45° FOV — 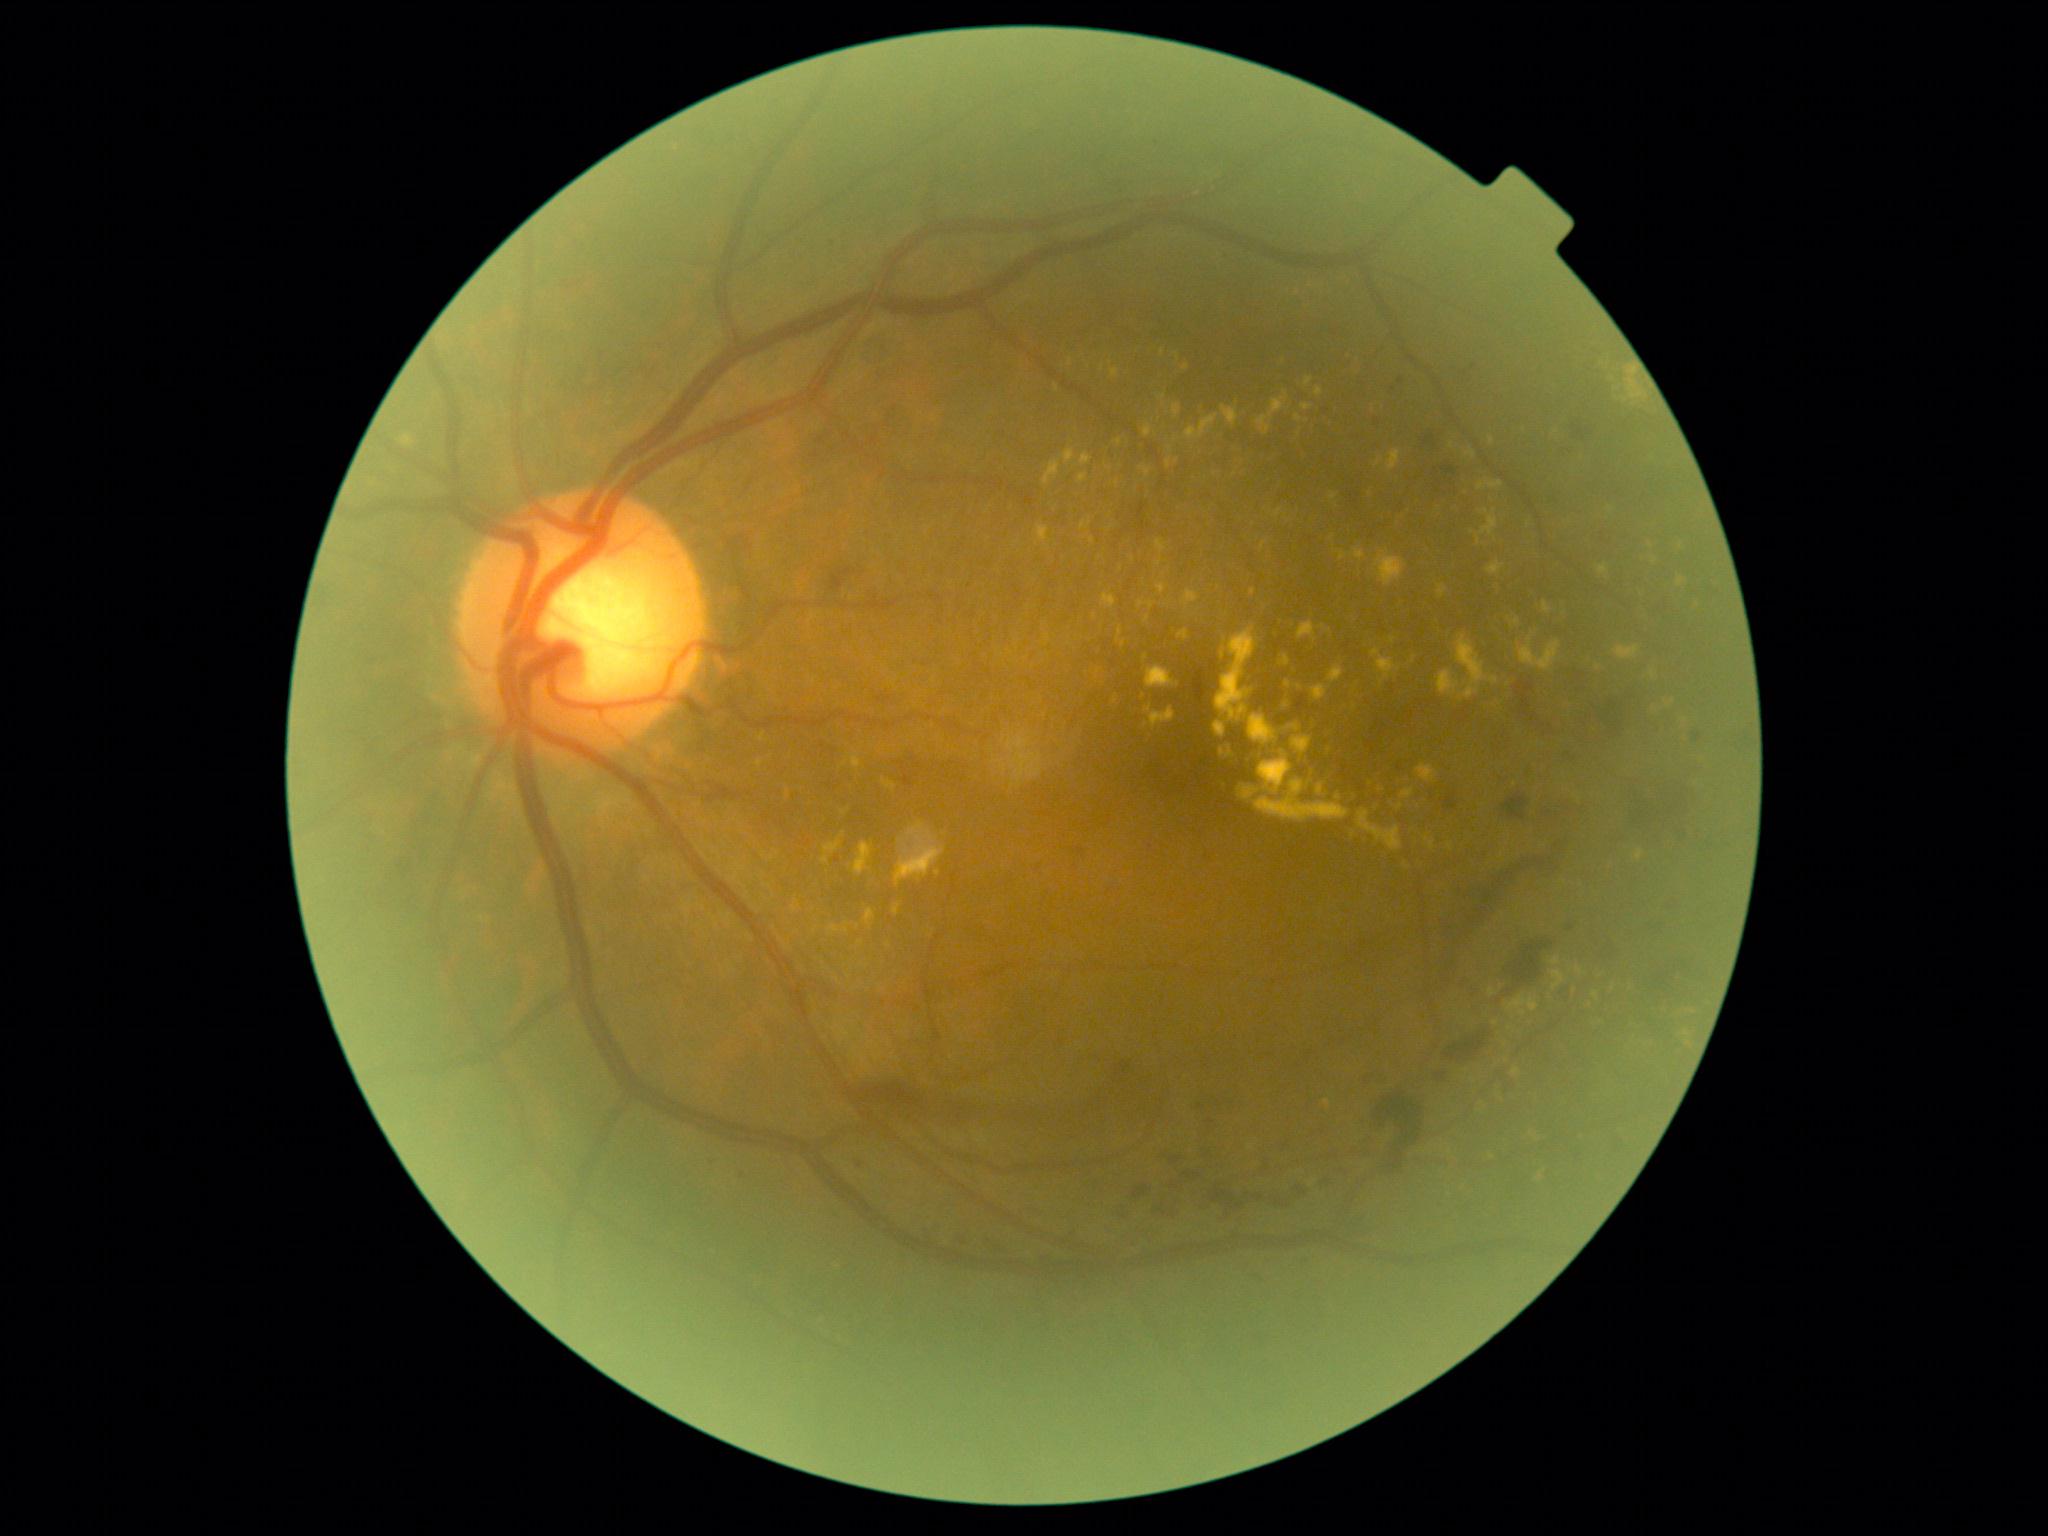

DR: 2.
EXs are present, including at l=1673, t=540, r=1683, b=548; l=1518, t=639, r=1562, b=672; l=1156, t=559, r=1163, b=567; l=1387, t=450, r=1401, b=471; l=1295, t=685, r=1303, b=691; l=1102, t=594, r=1117, b=608; l=1178, t=630, r=1189, b=640; l=1175, t=353, r=1180, b=361; l=1507, t=994, r=1540, b=1013; l=1438, t=585, r=1448, b=600; l=1592, t=991, r=1599, b=1001; l=1274, t=509, r=1283, b=519.
EXs (small, approximate centers) near [1370,494]; [1674,701]; [1323,628]; [1655,561]; [1171,450]; [1092,540].